Wide-field fundus photograph of an infant · camera: Phoenix ICON (100° FOV) — 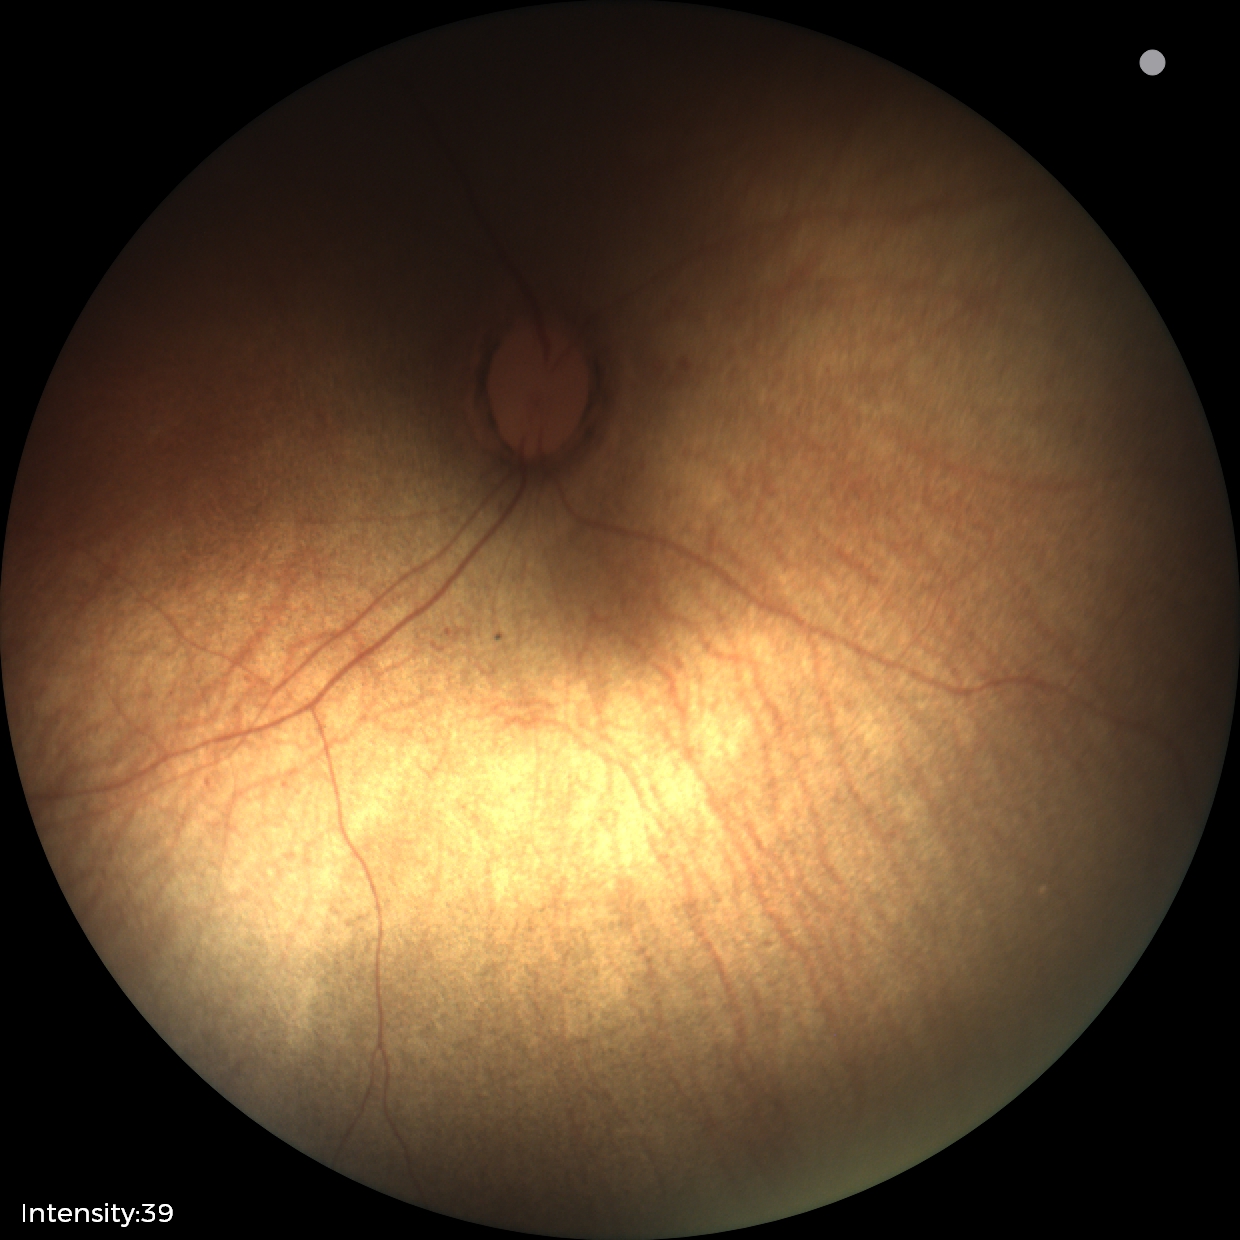 Screening examination diagnosed as physiological.